CFP. 848x848px
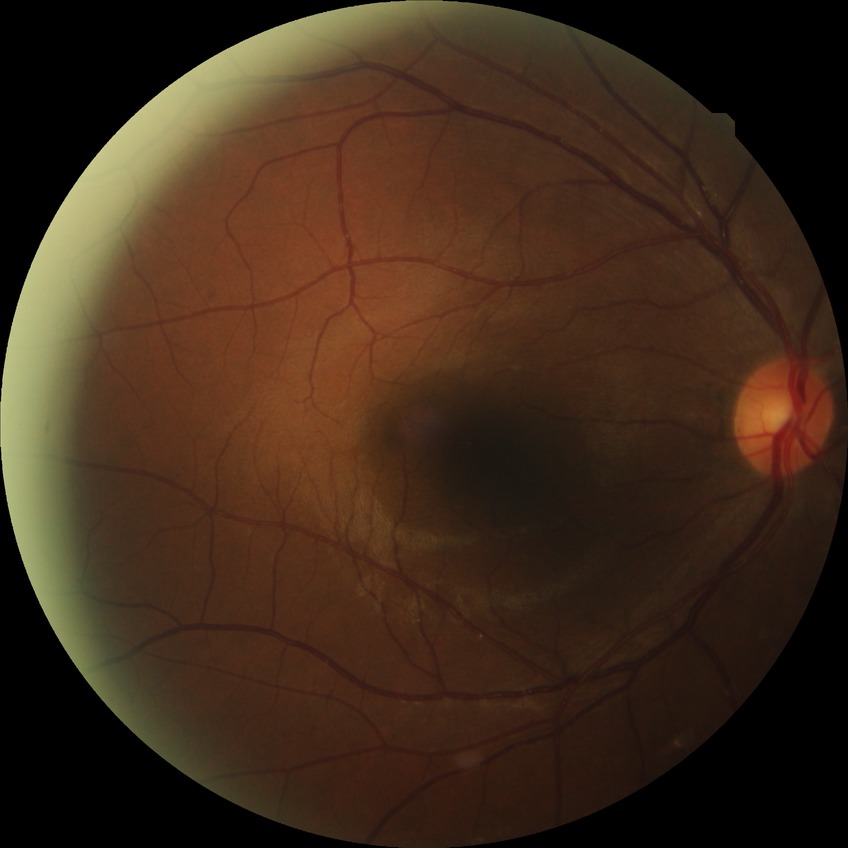
davis_grade: NDR (no diabetic retinopathy)